Color fundus photograph; 45° FOV; 2212 by 1659 pixels
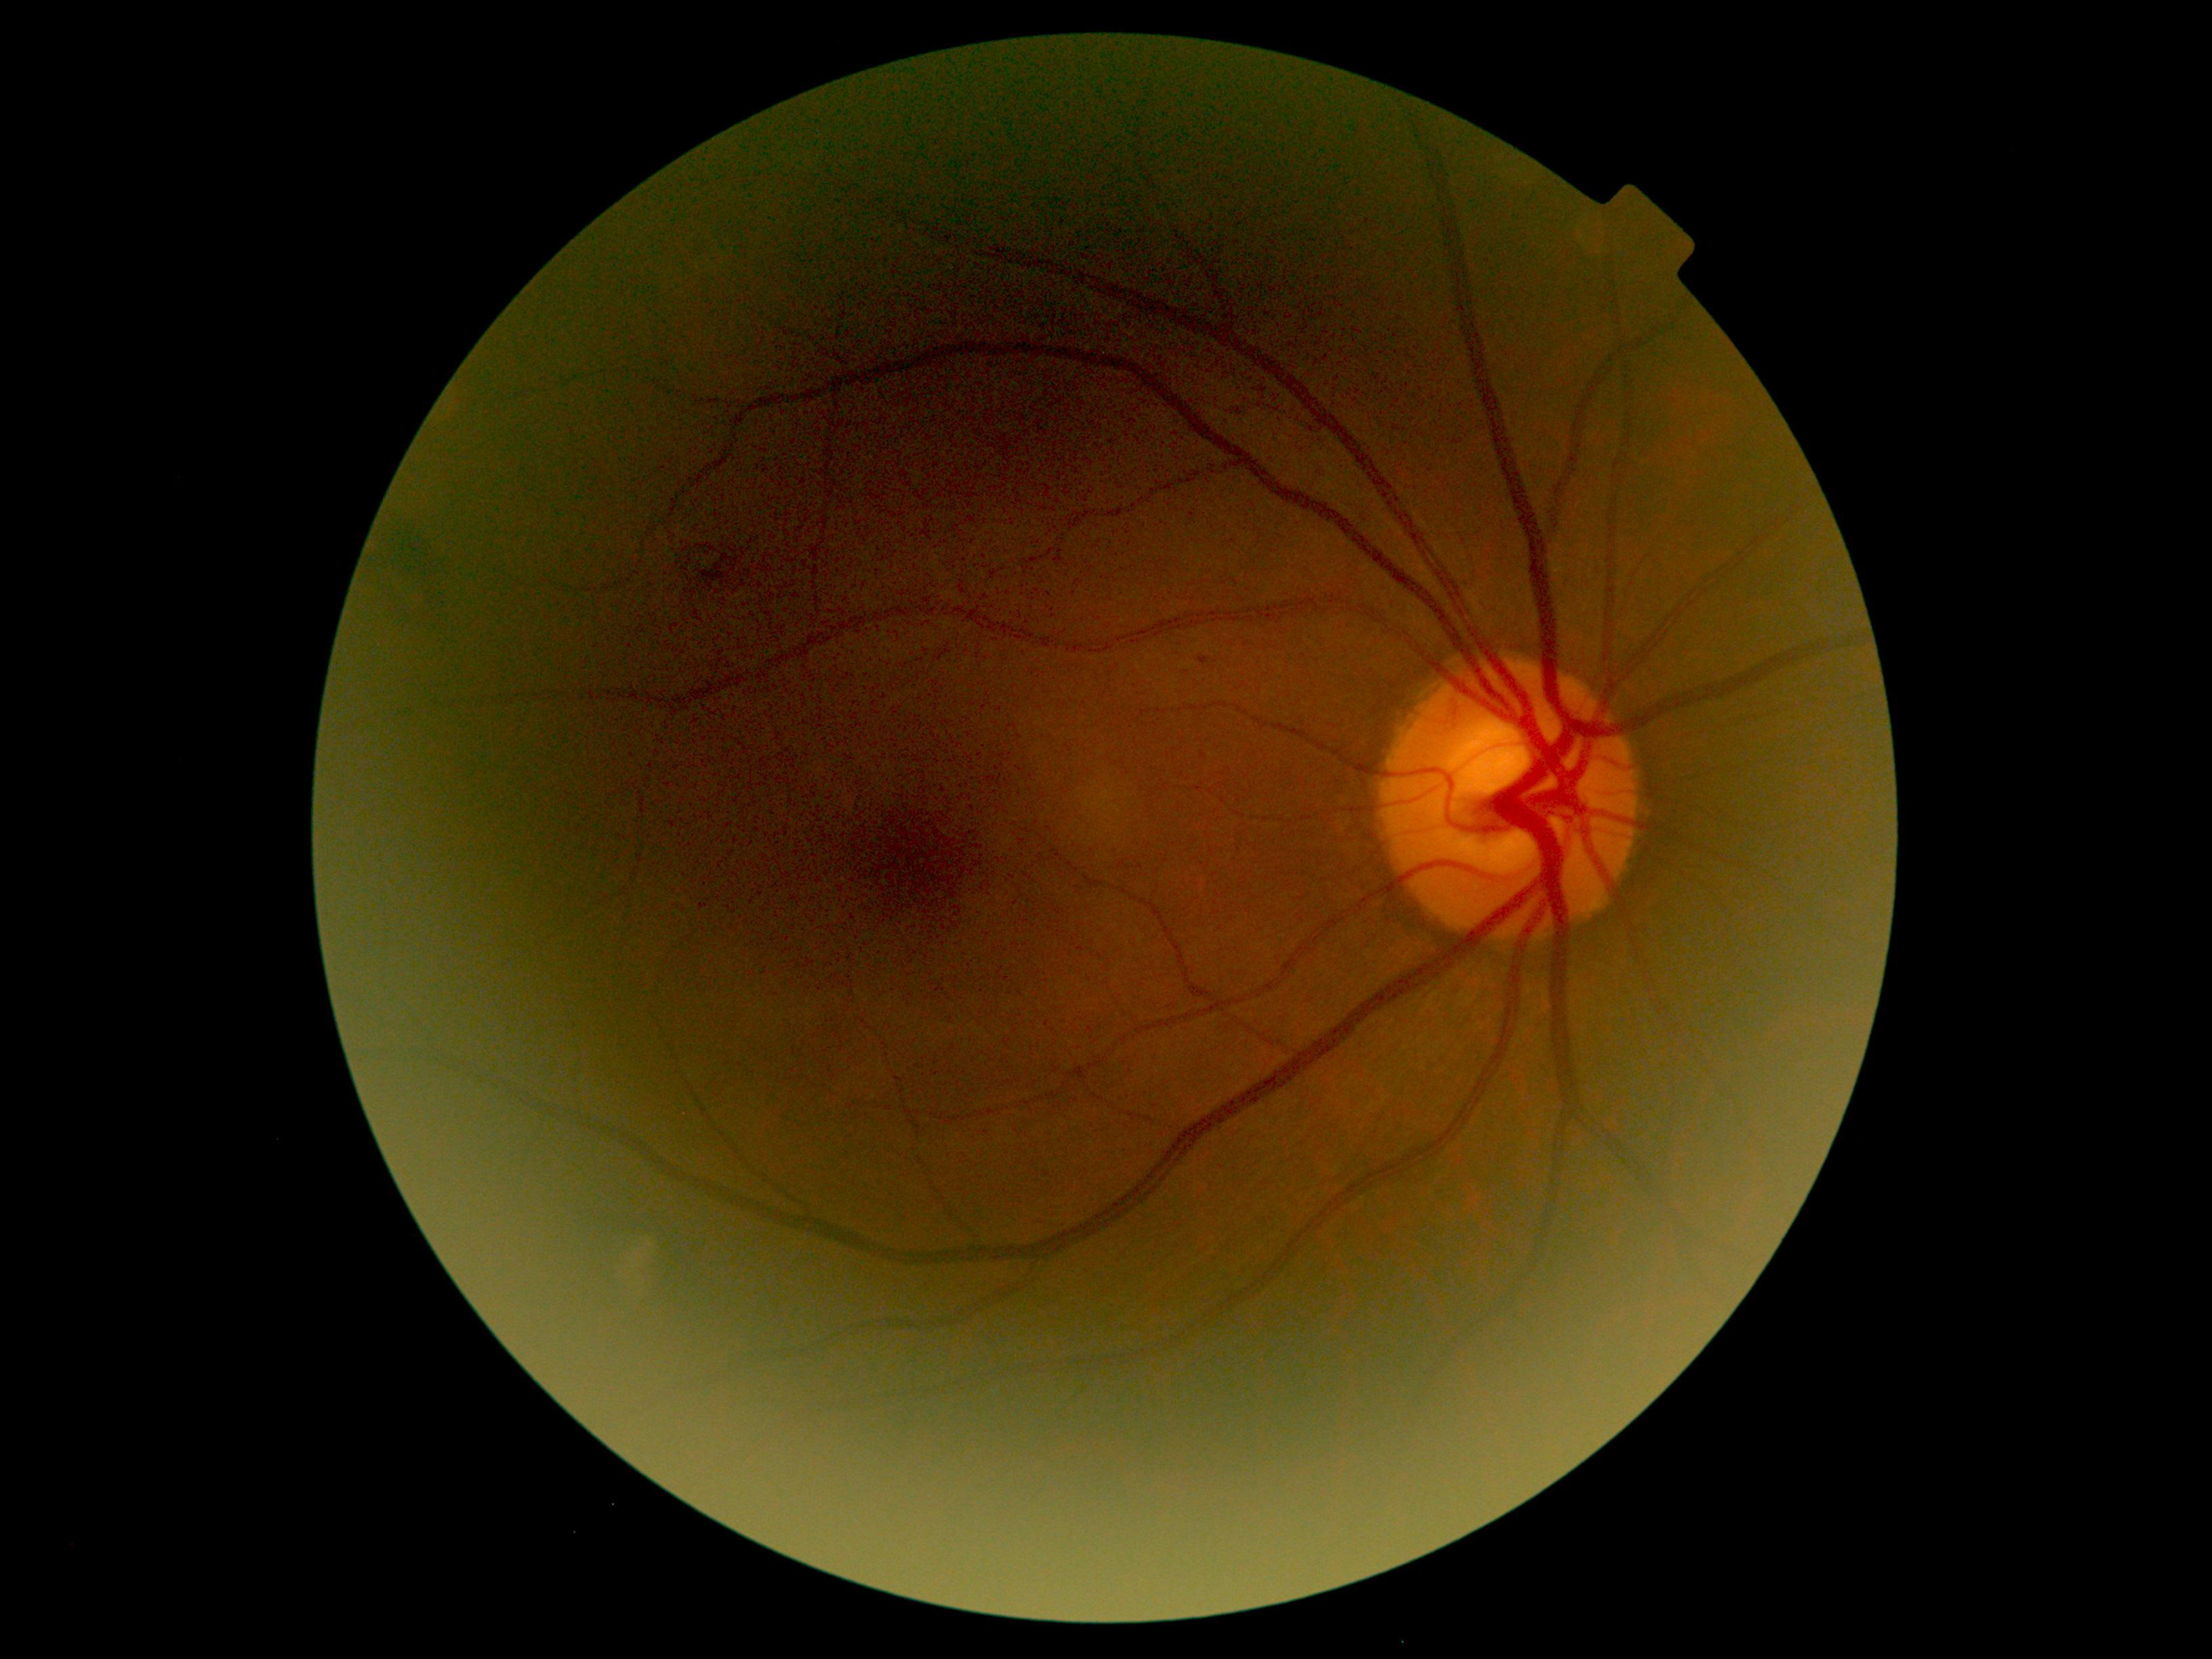
DR grade is 2 (moderate NPDR) — more than just microaneurysms but less than severe NPDR.